Acquired with a Topcon TRC-NW8. 50° field of view. Fundus photo — 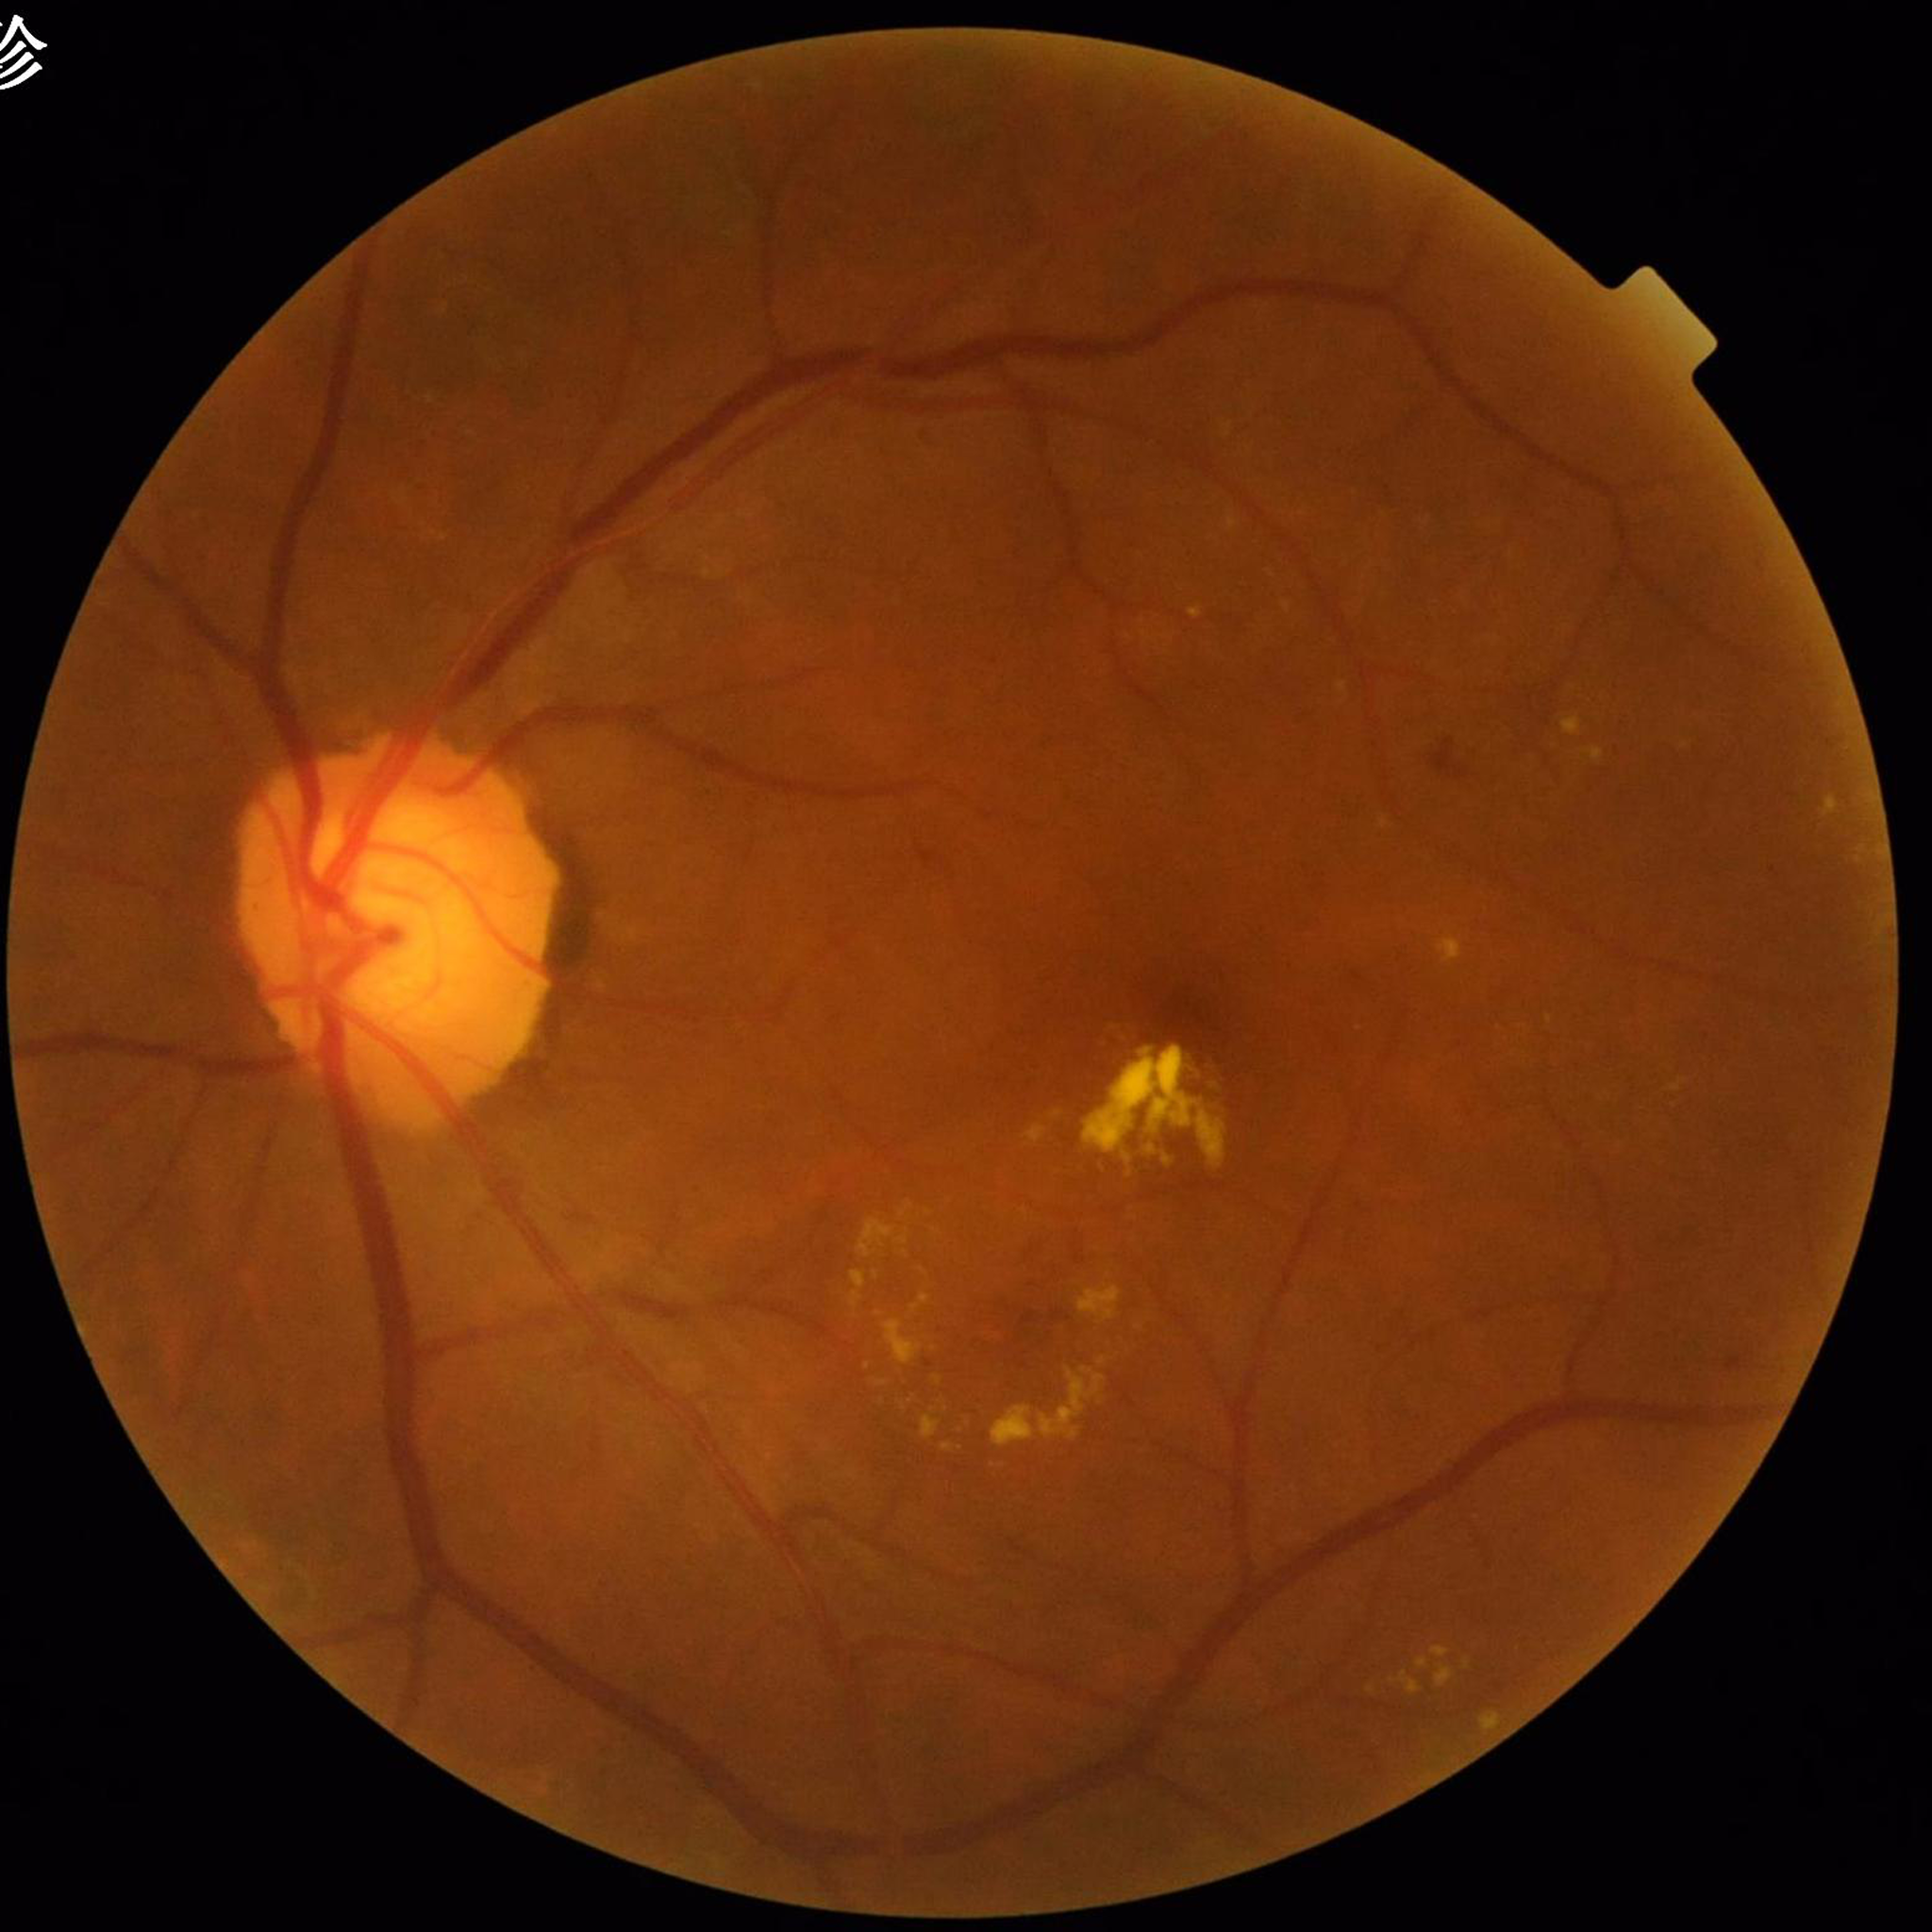 Condition: DR.